Optic disc-centered crop · Nidek AFC-330 · non-mydriatic.
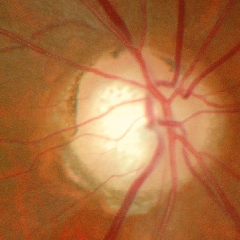 Glaucomatous optic neuropathy is present. Diagnosis = early-stage glaucoma.